848 by 848 pixels, retinal fundus photograph, acquired with a NIDEK AFC-230 — 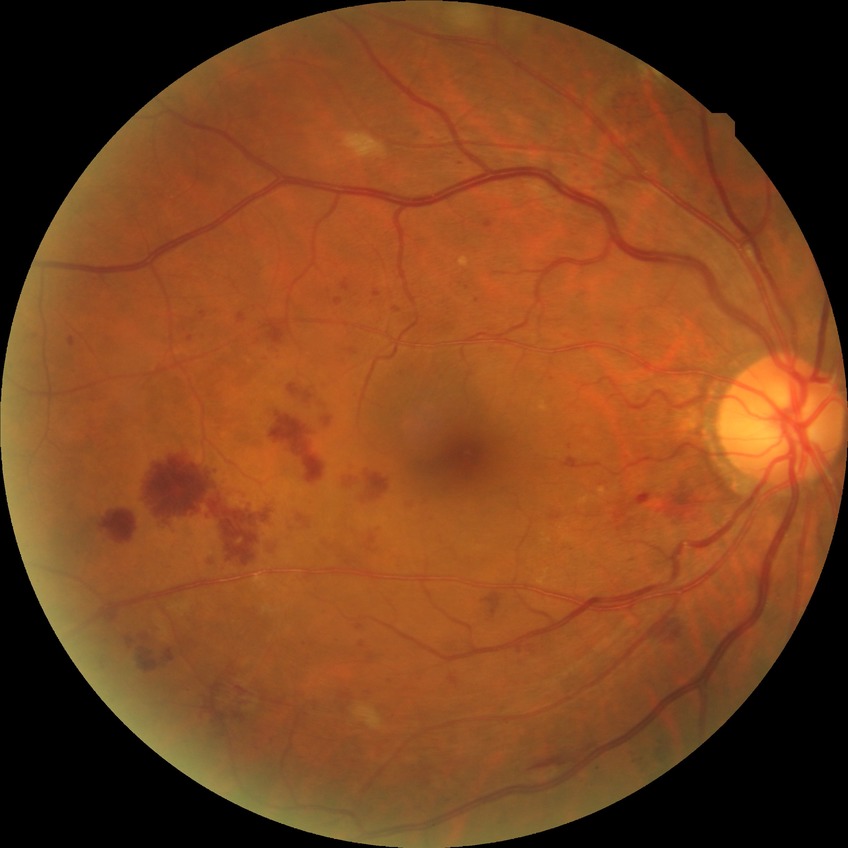
Diabetic retinopathy stage: pre-proliferative diabetic retinopathy.